Fundus photo:
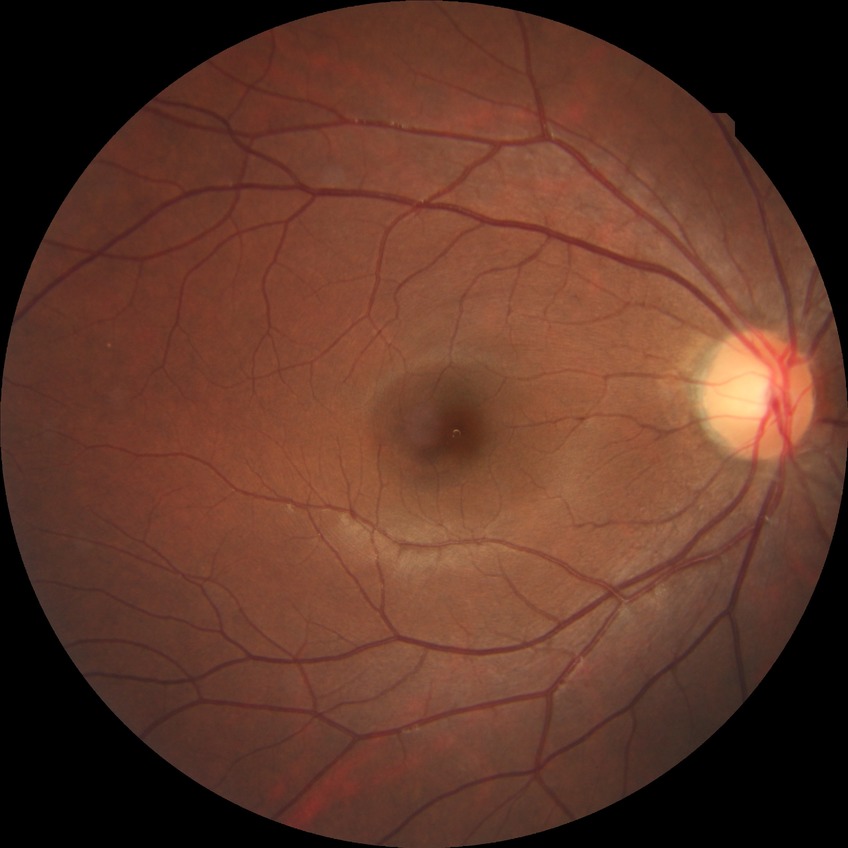

No diabetic retinal disease findings. Modified Davis grade is NDR.